Color fundus image:
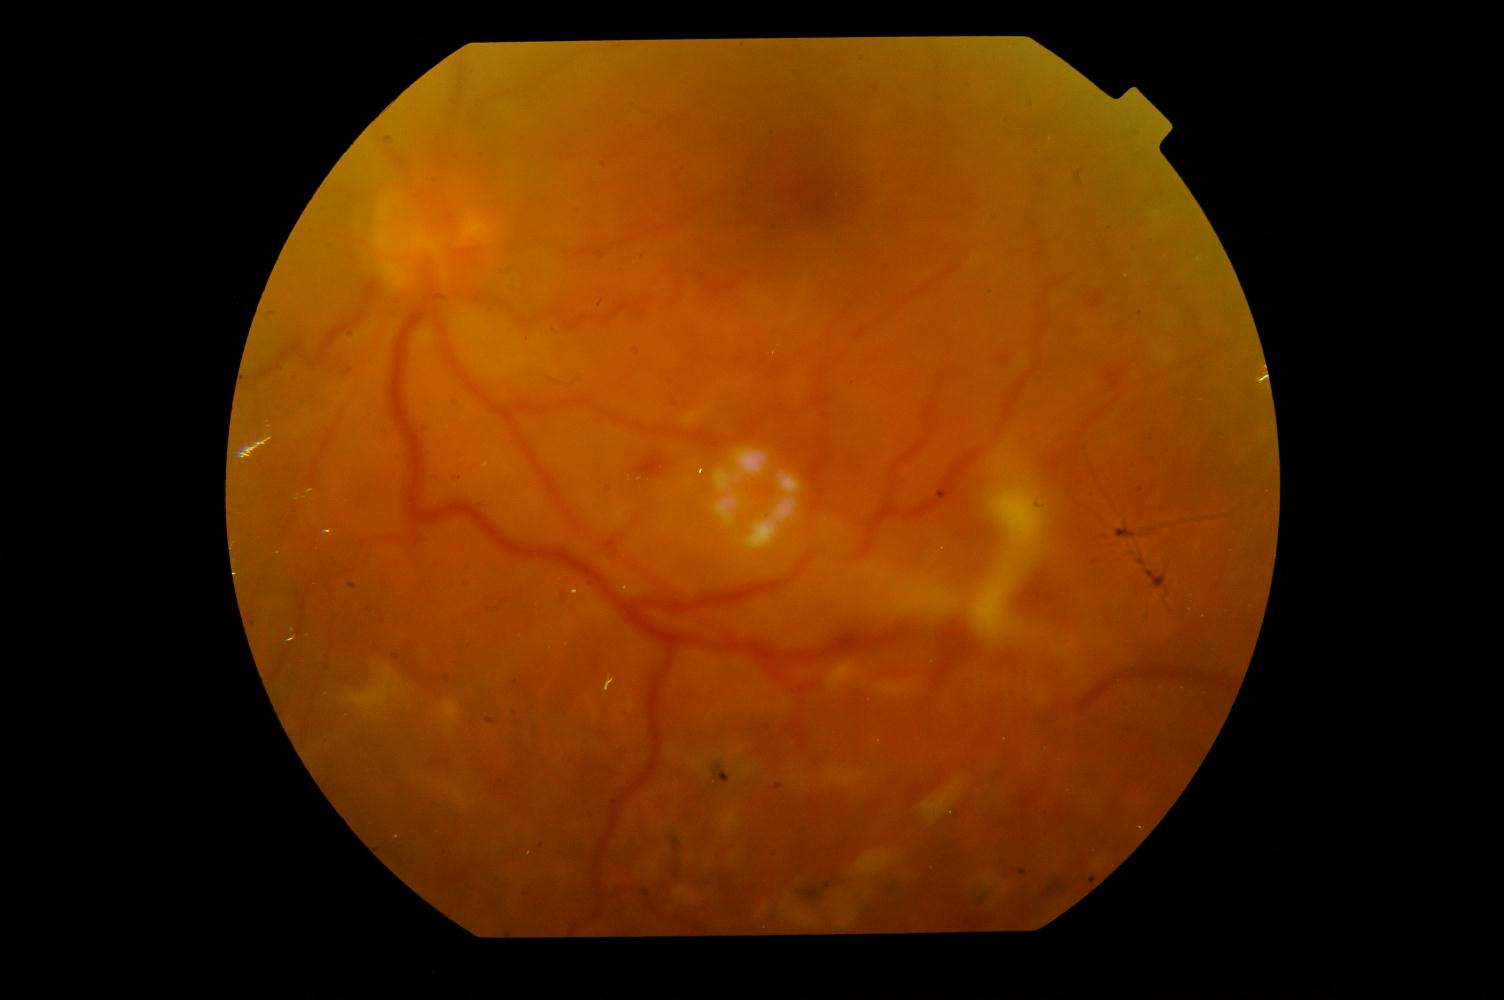 Impression: diabetic retinopathy.